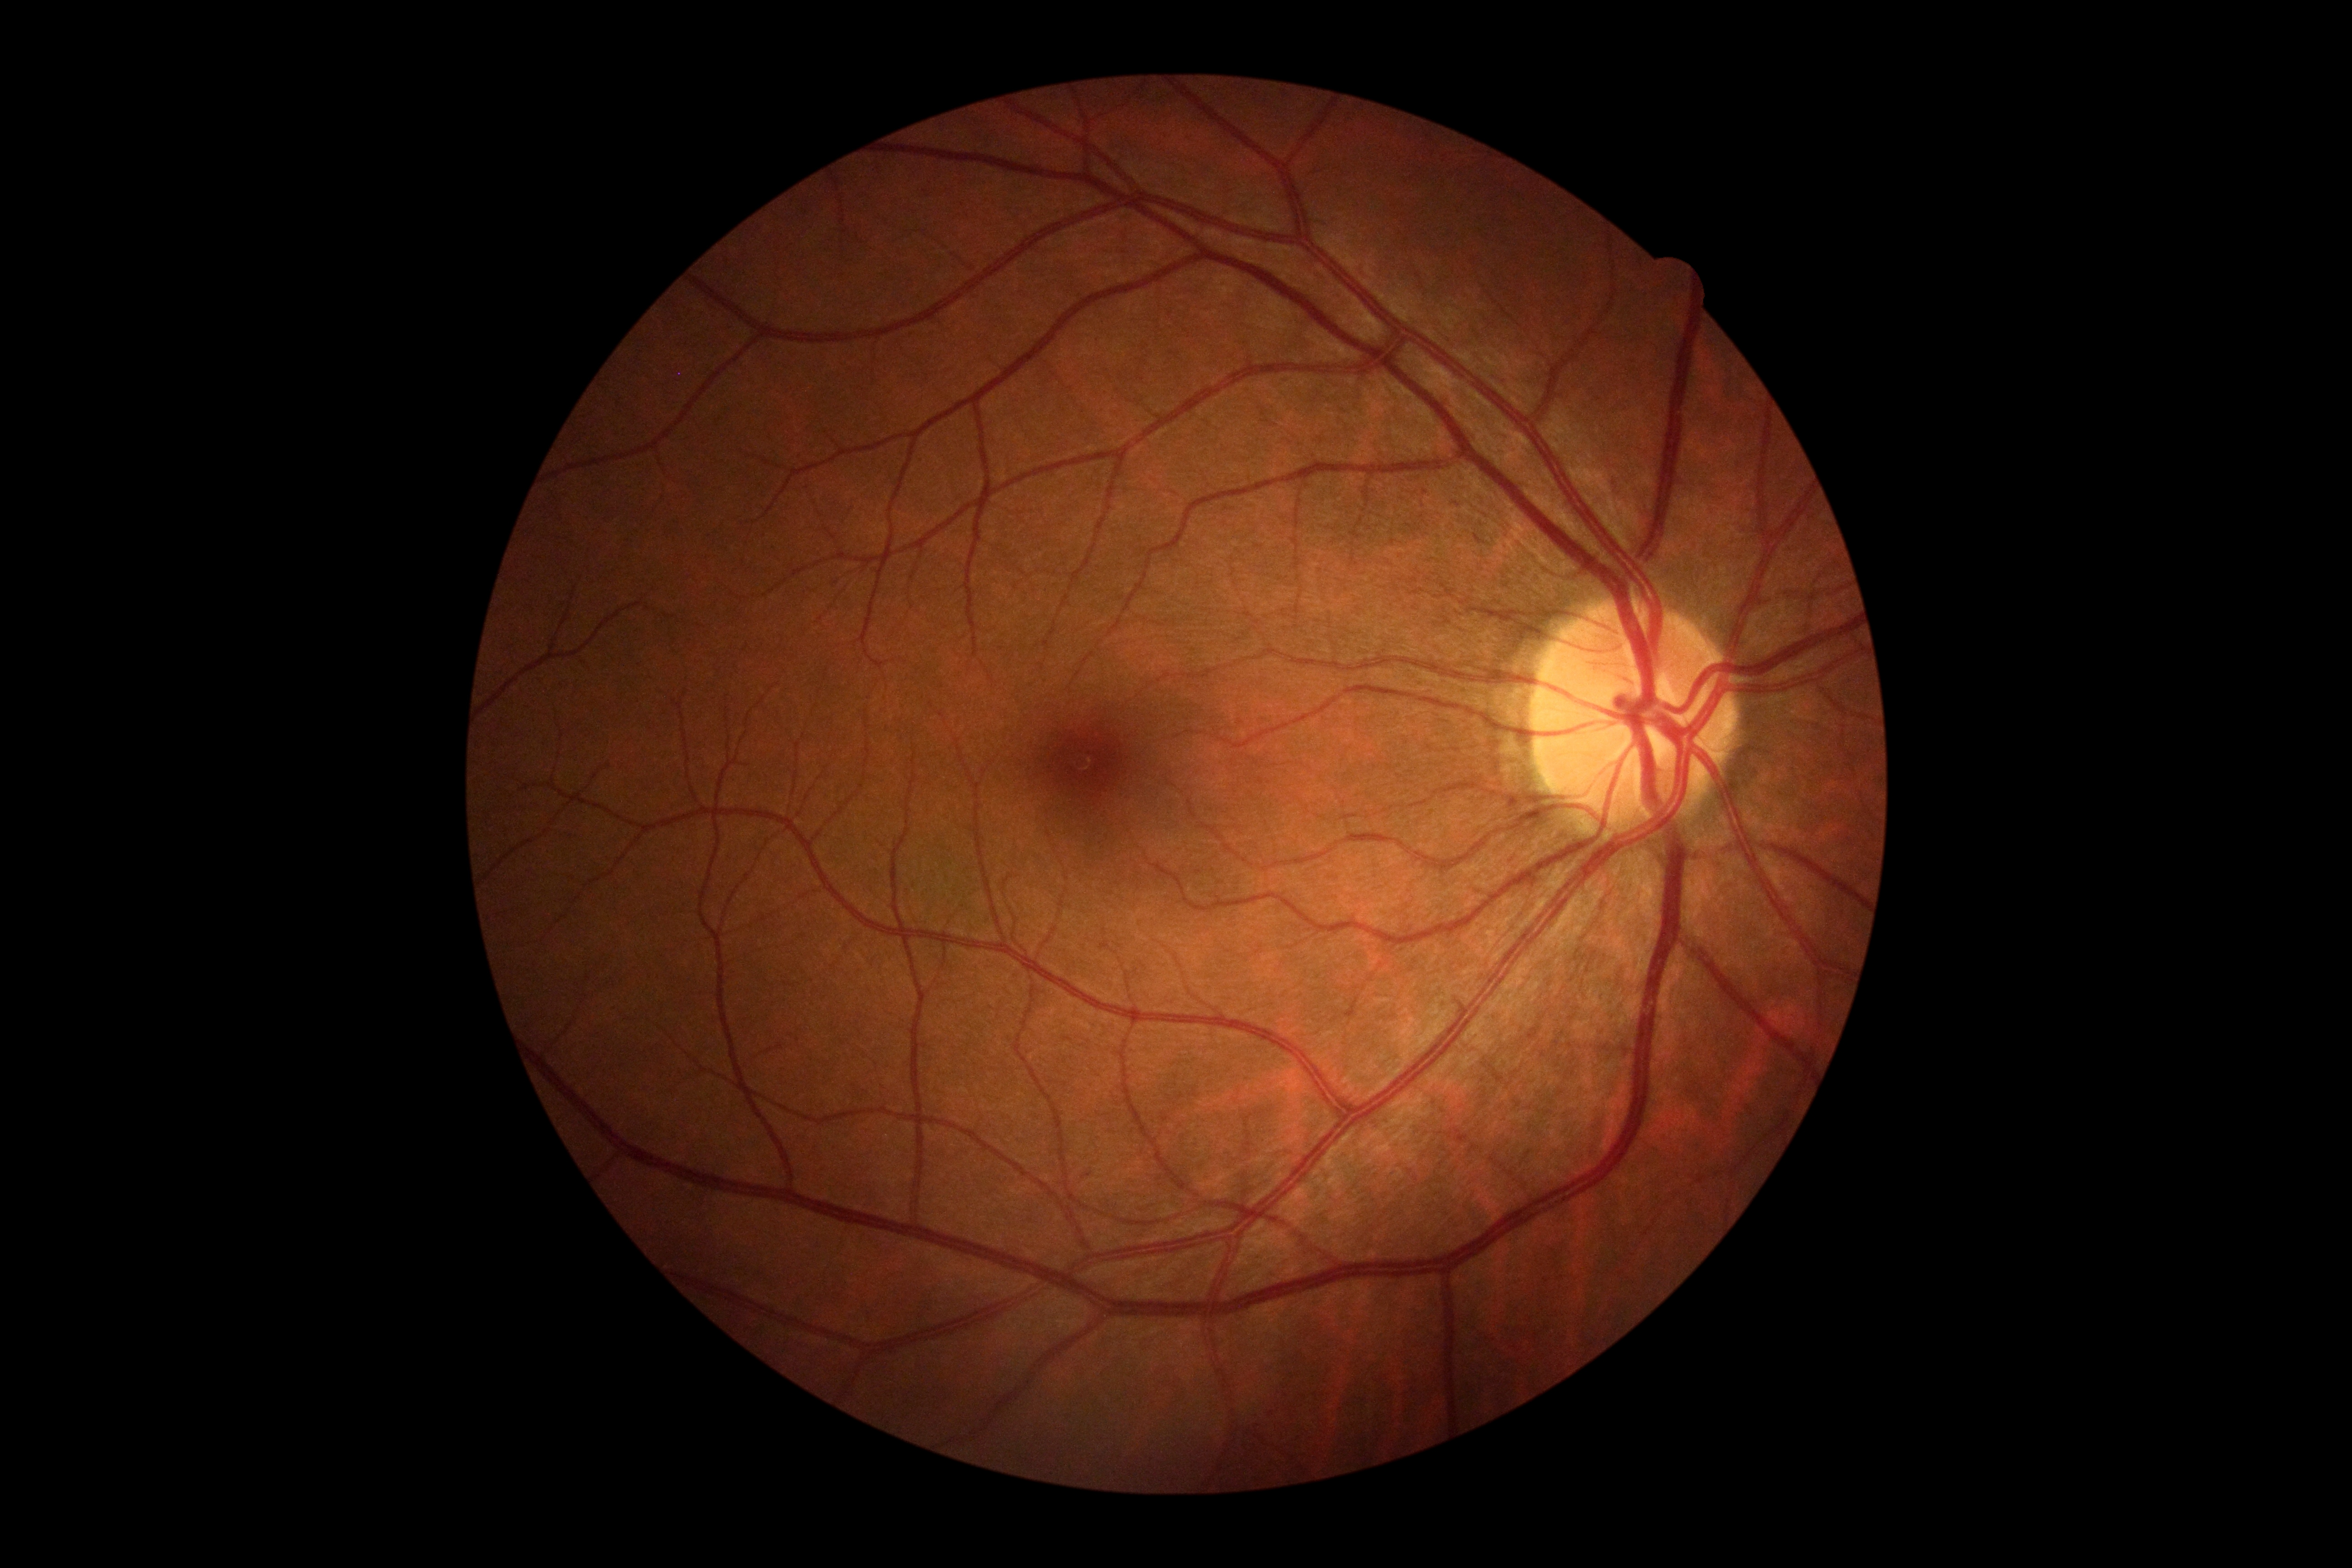
Diabetic retinopathy (DR) is grade 0 (no apparent retinopathy) — no visible signs of diabetic retinopathy.